Infant wide-field fundus photograph. Captured with the Phoenix ICON (100° field of view): 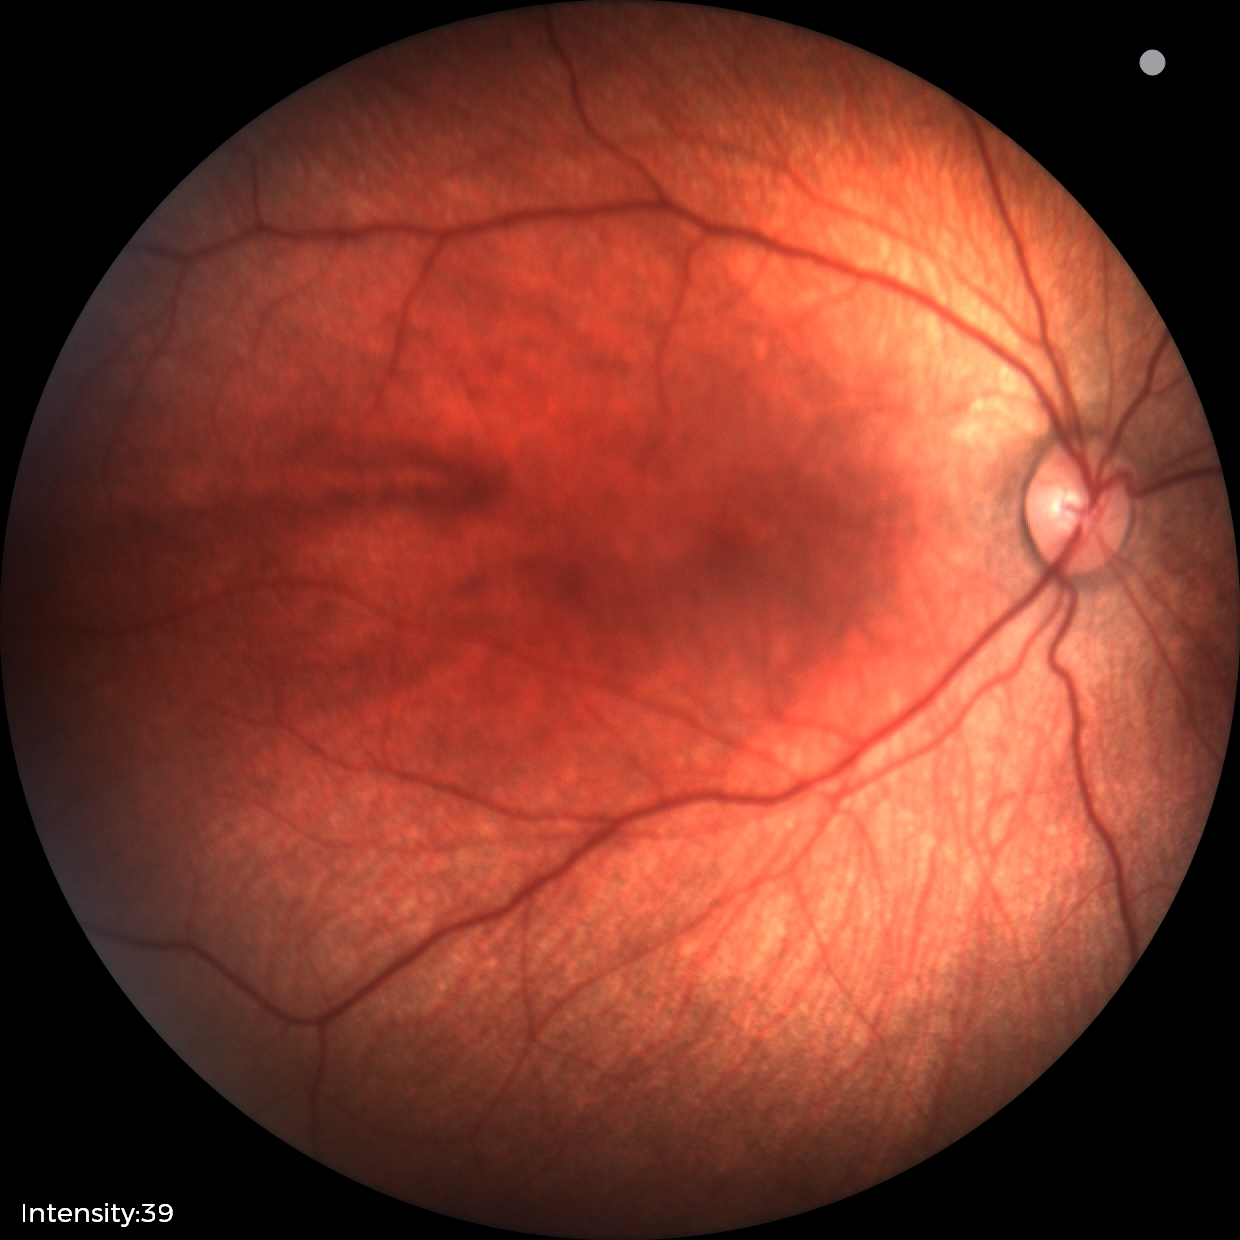
Screening: physiological finding.